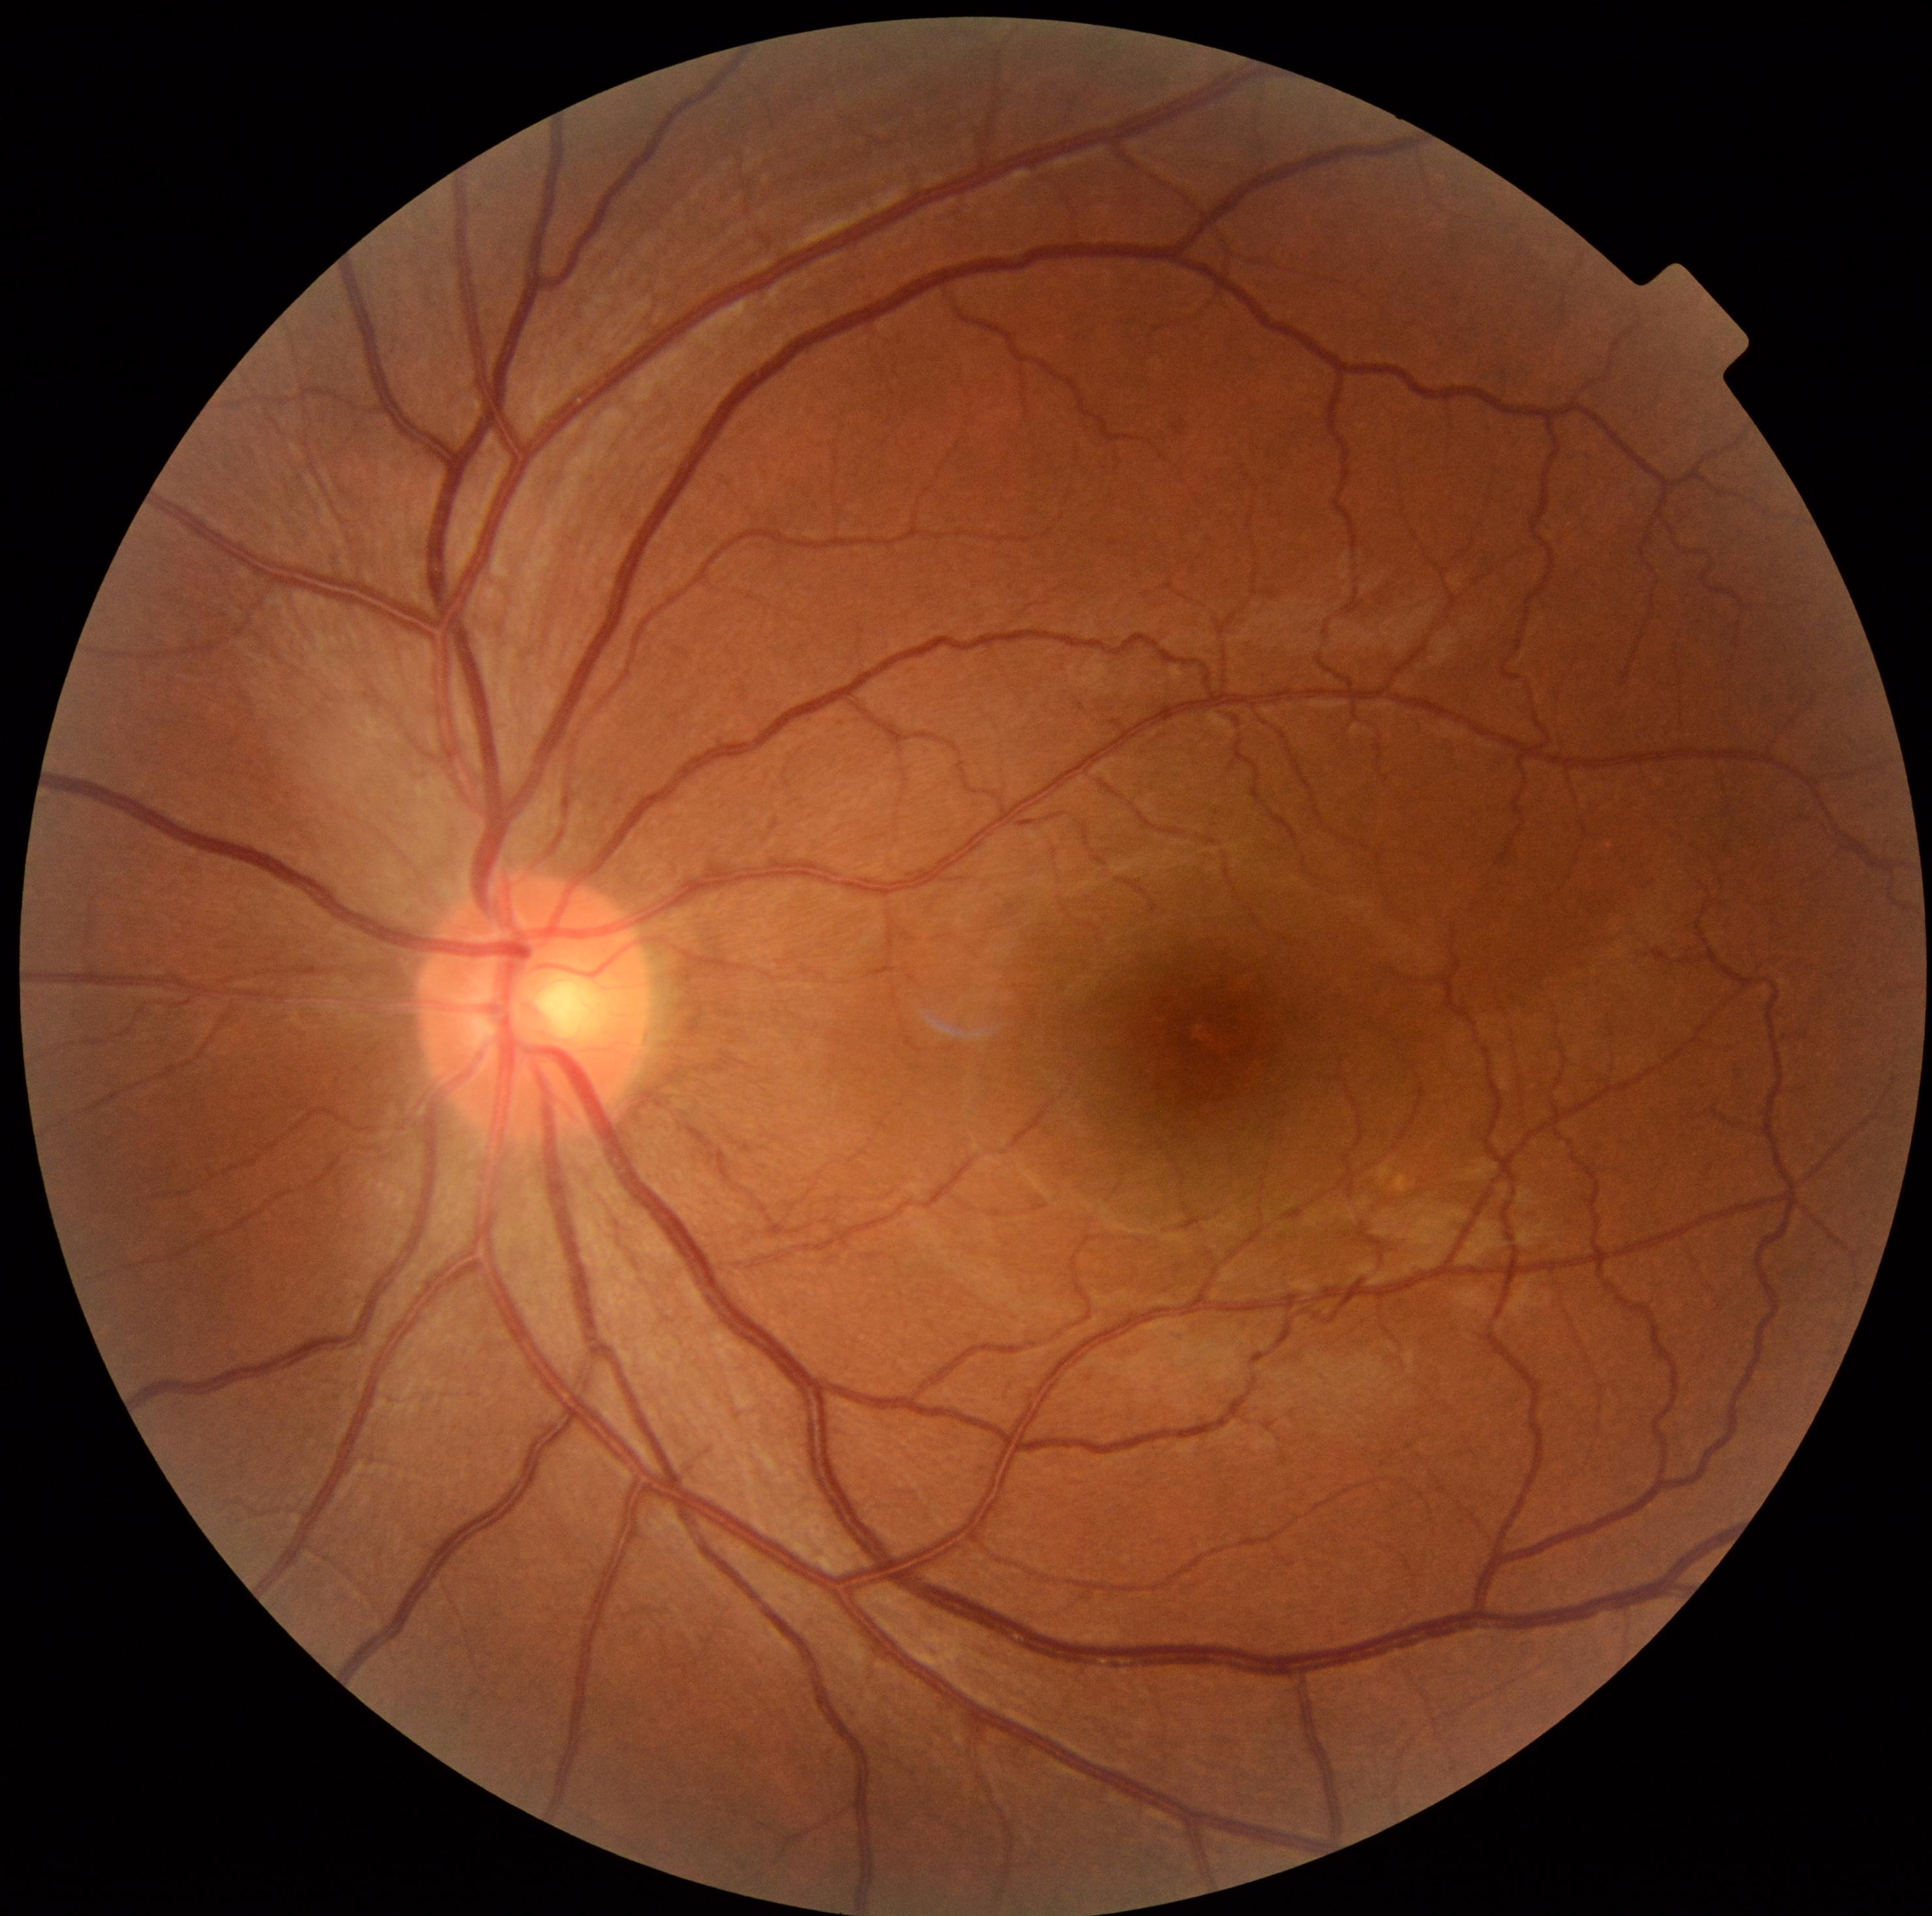
diabetic retinopathy (DR): grade 0 — no visible signs of diabetic retinopathy.